2048 by 1536 pixels; color fundus image:
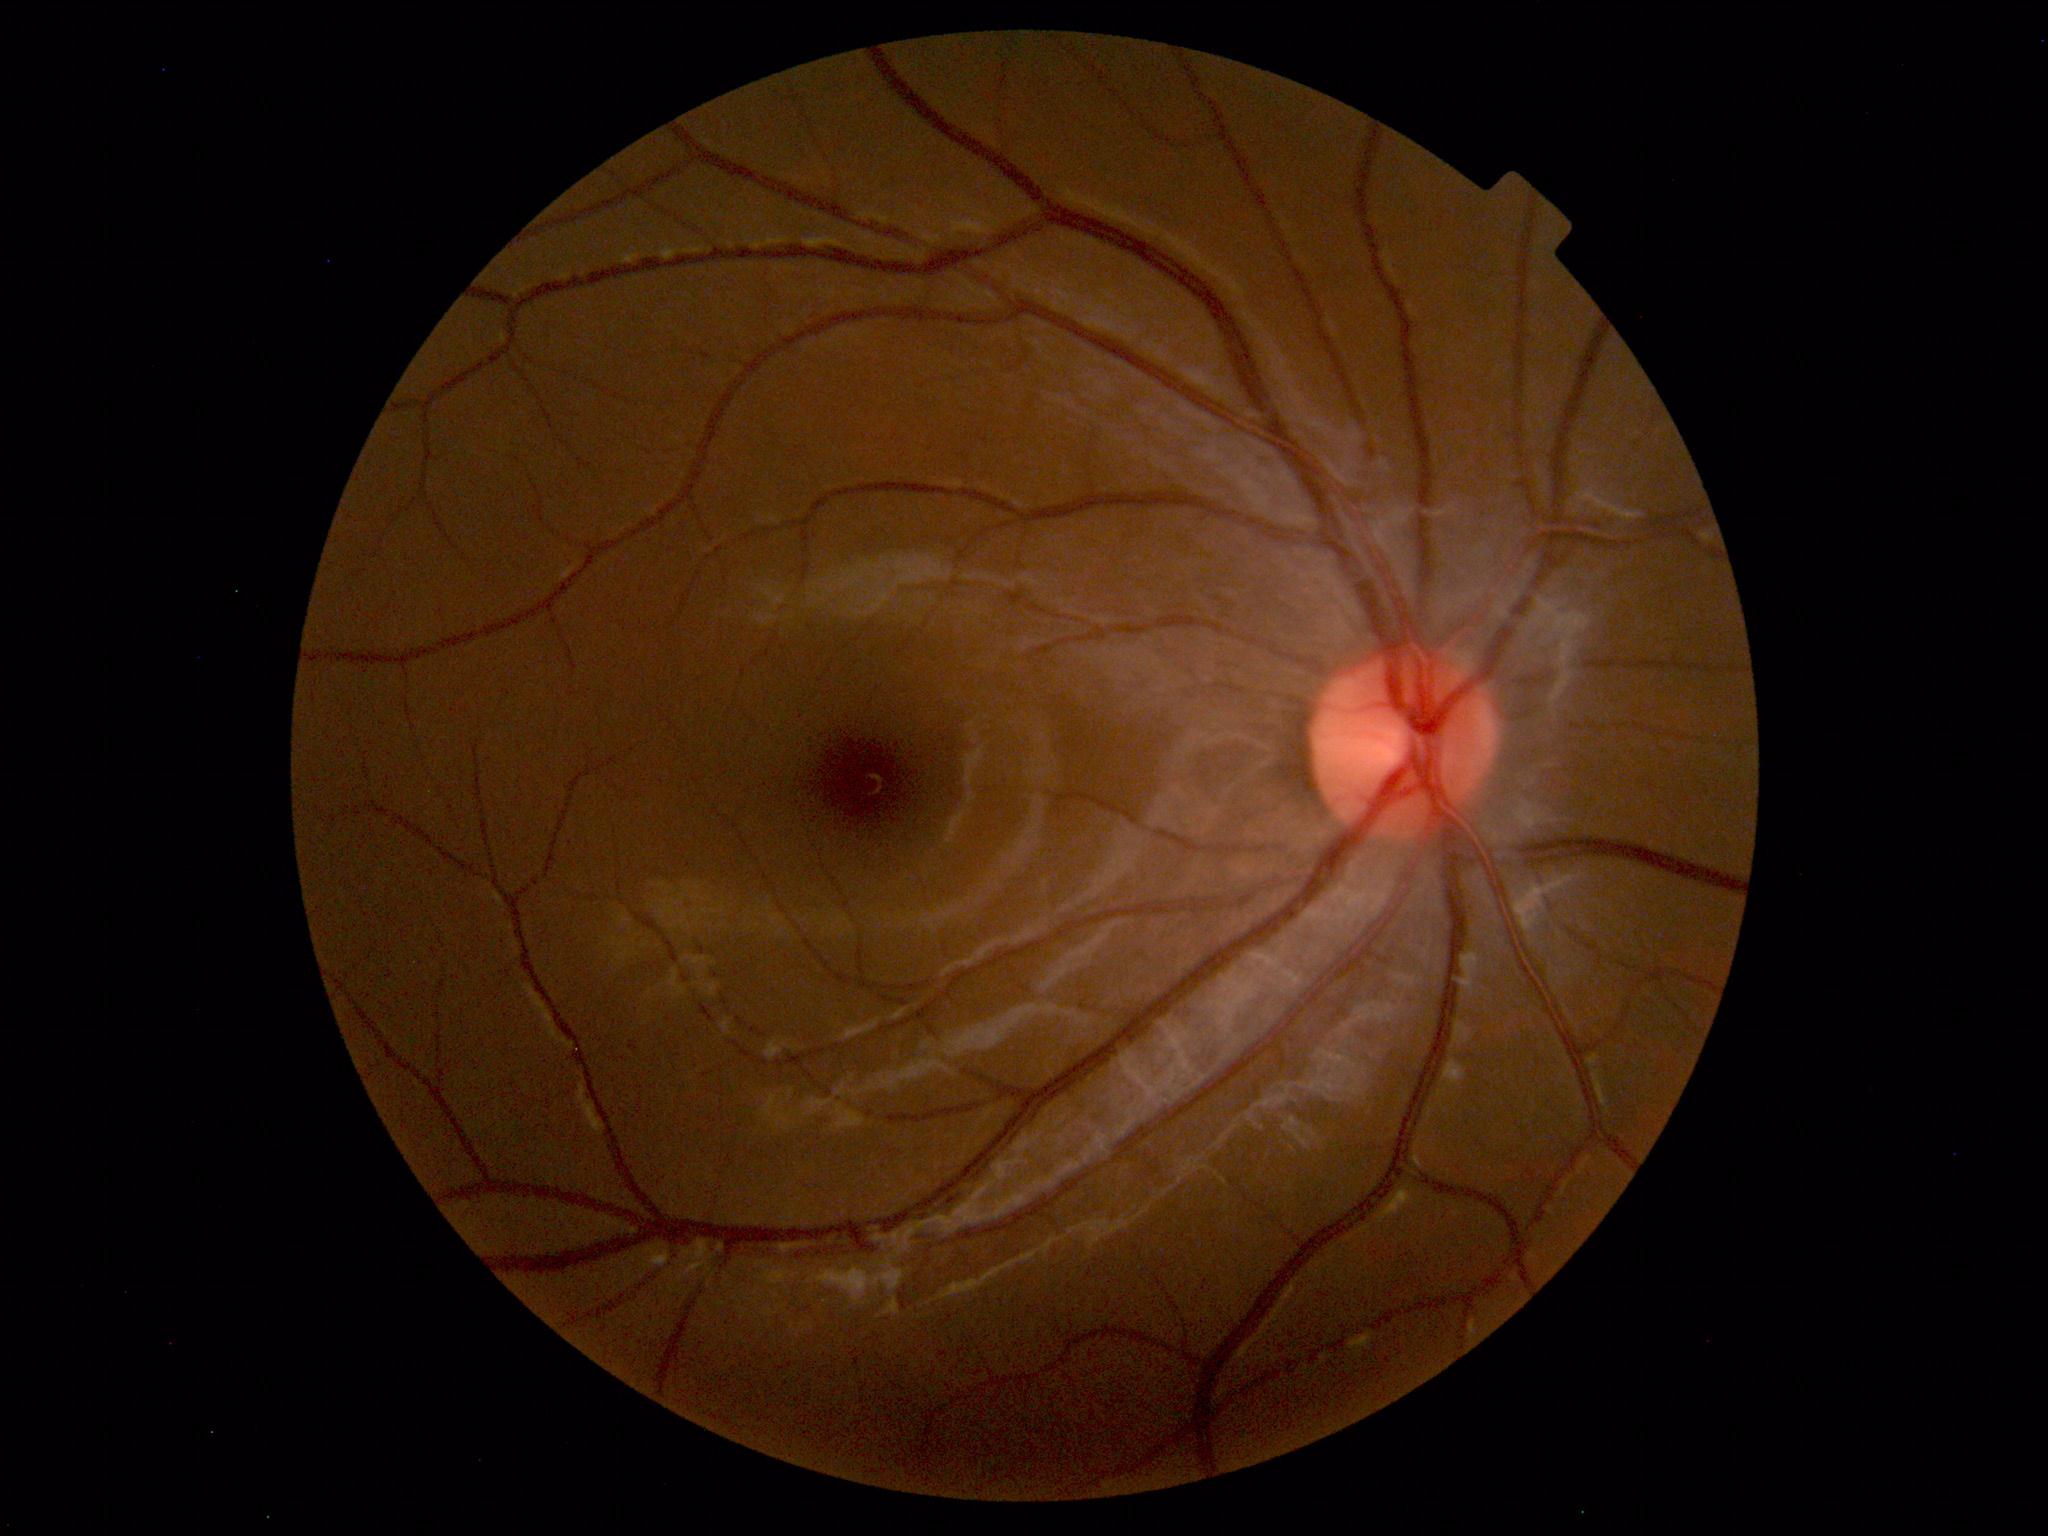
No retinal pathology identified.